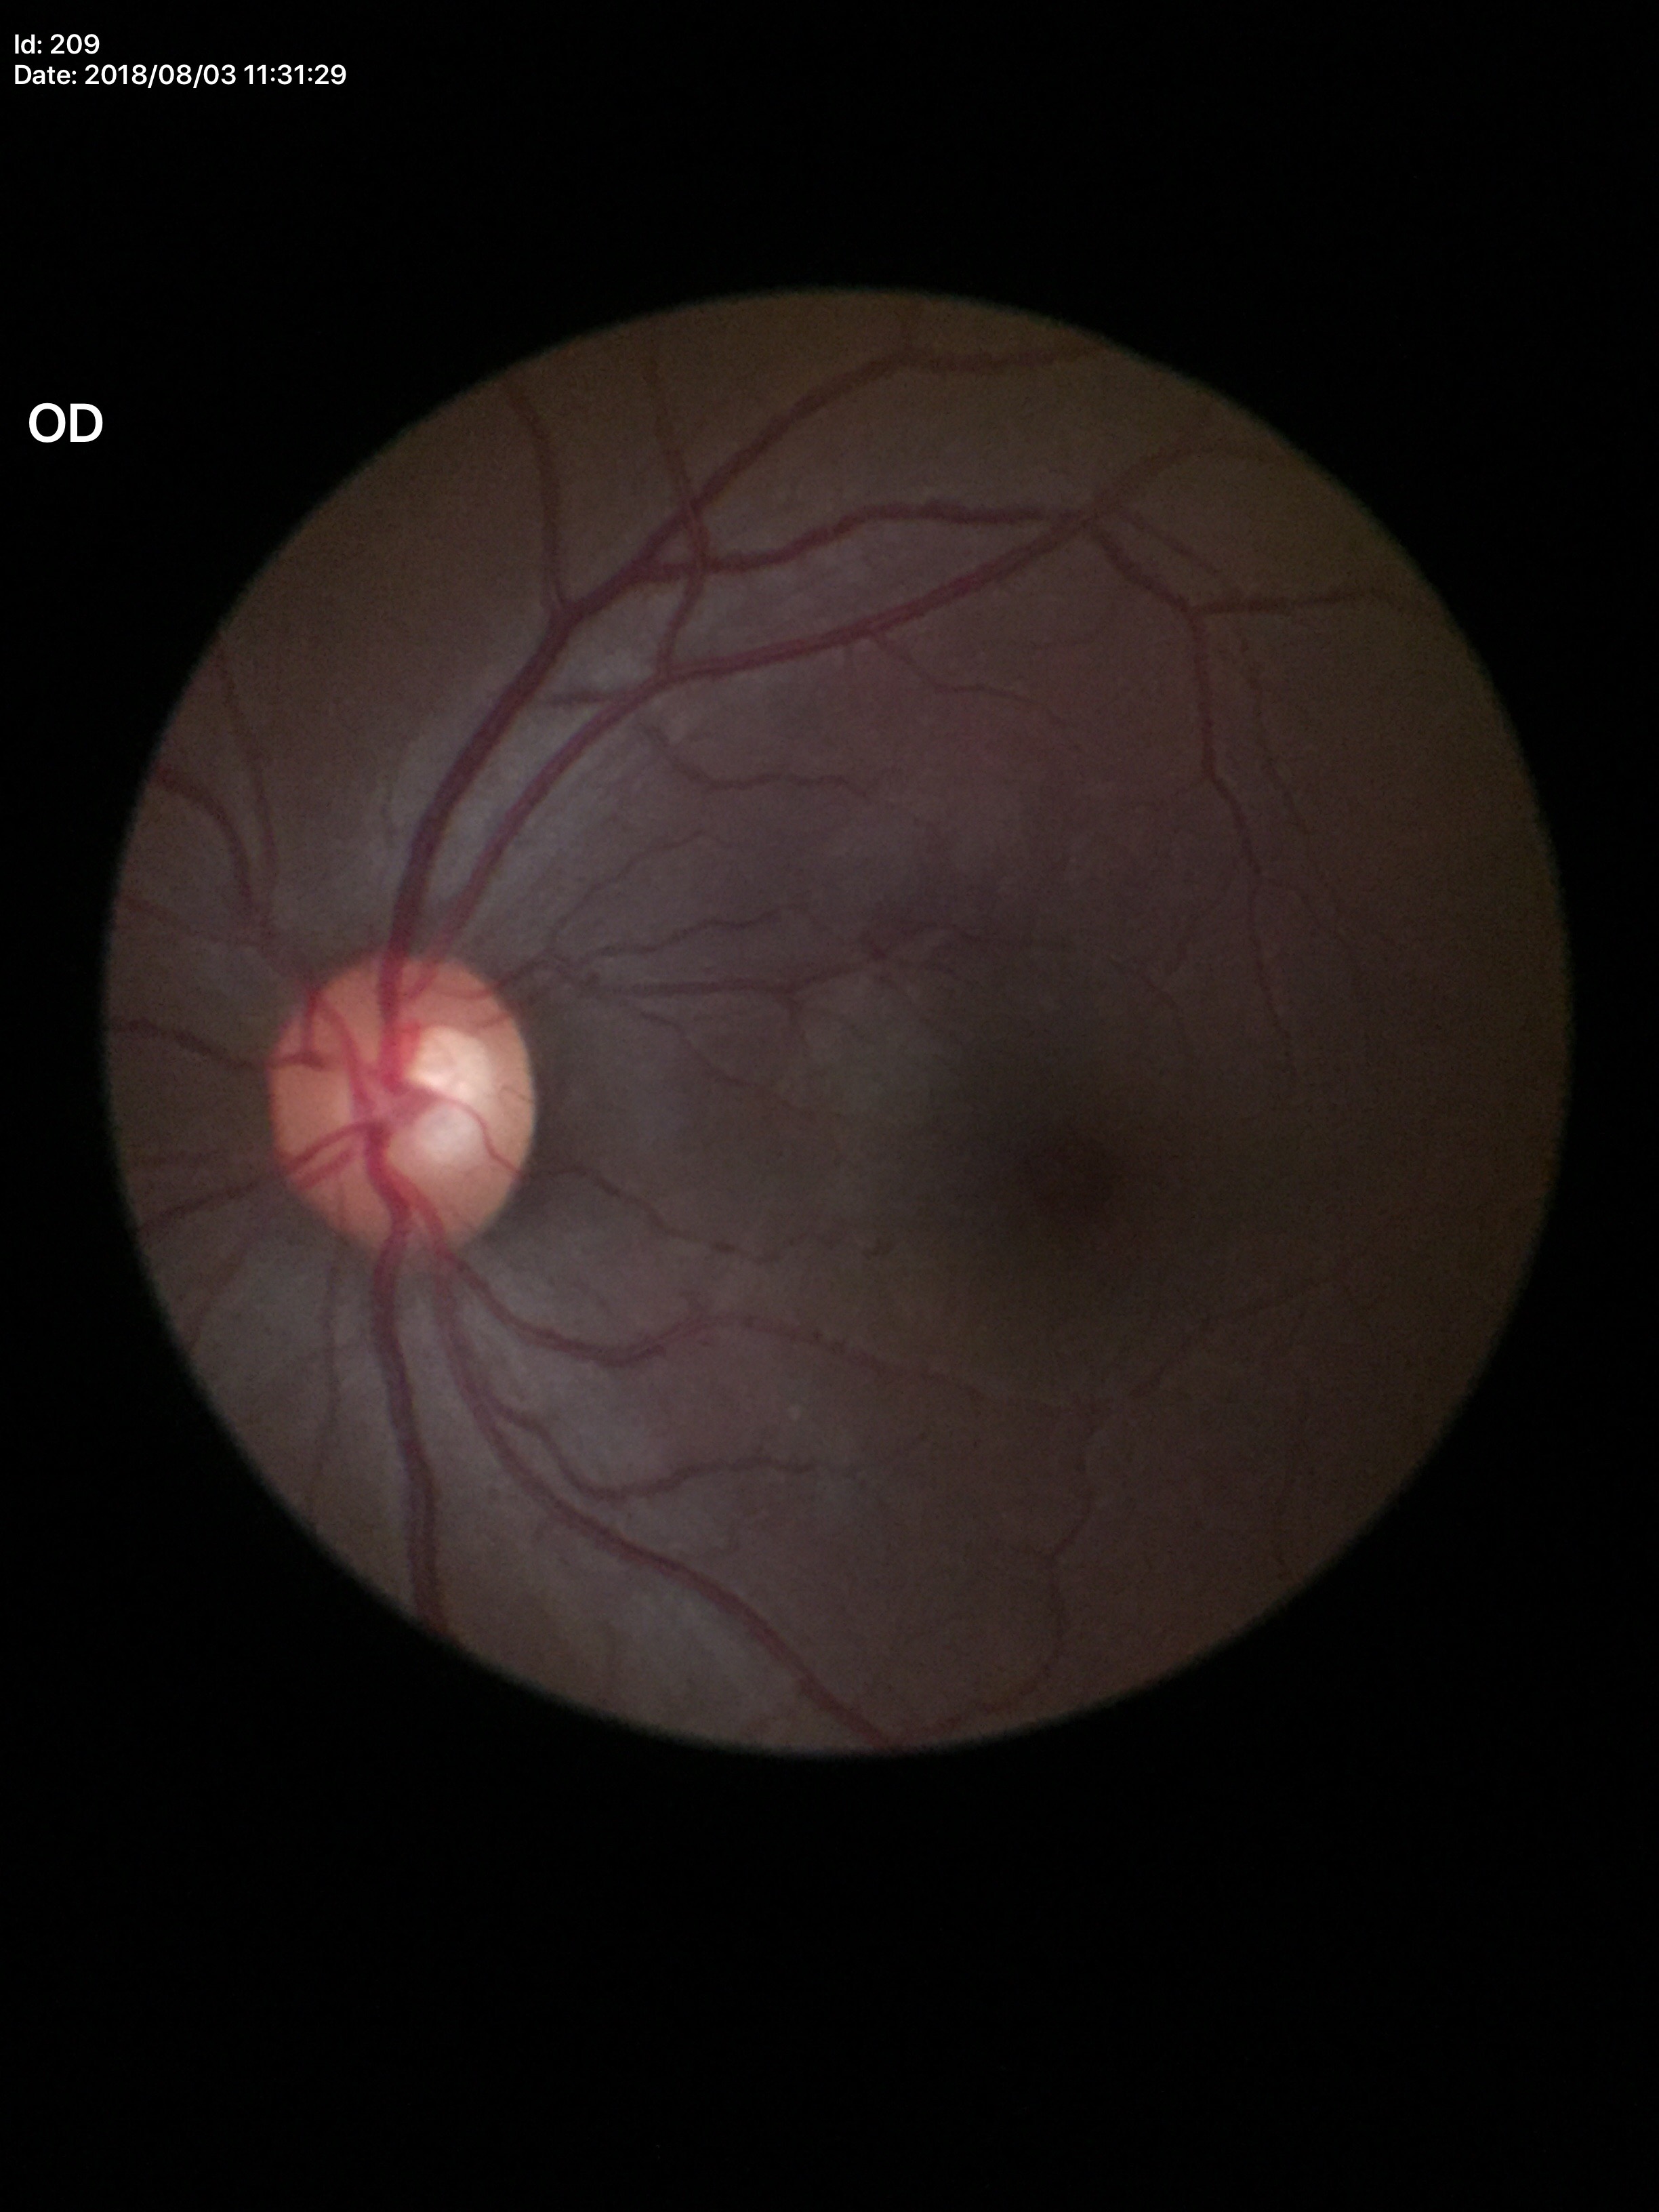
vertical C/D ratio: 0.54; Glaucoma impression: negative.